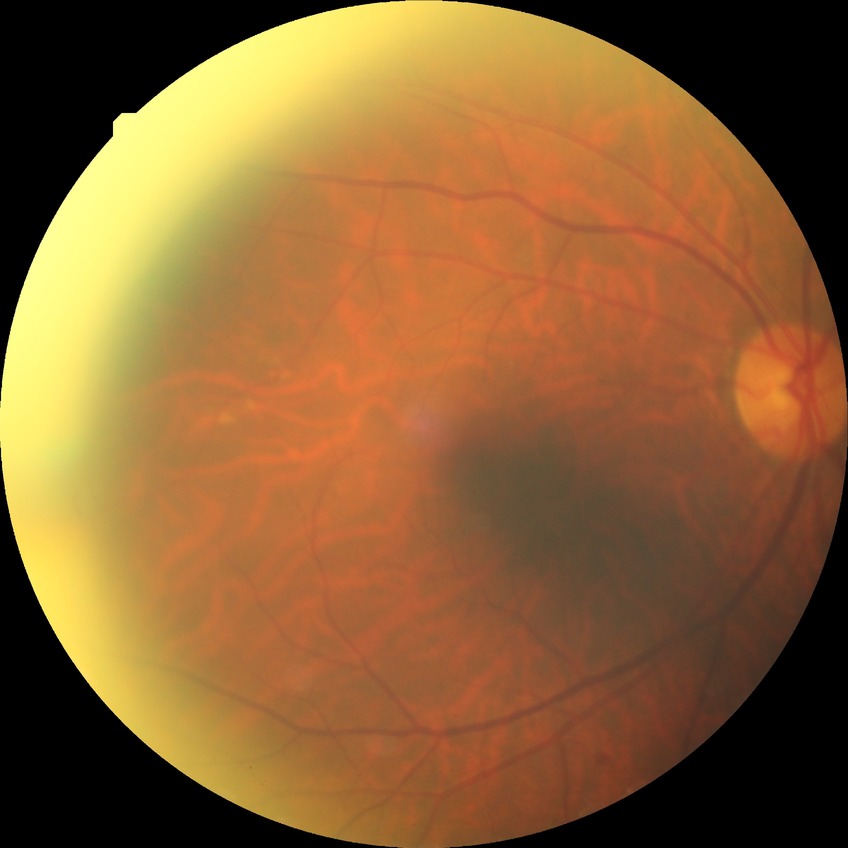 davis_grade: simple diabetic retinopathy